2048 by 1536 pixels · CFP
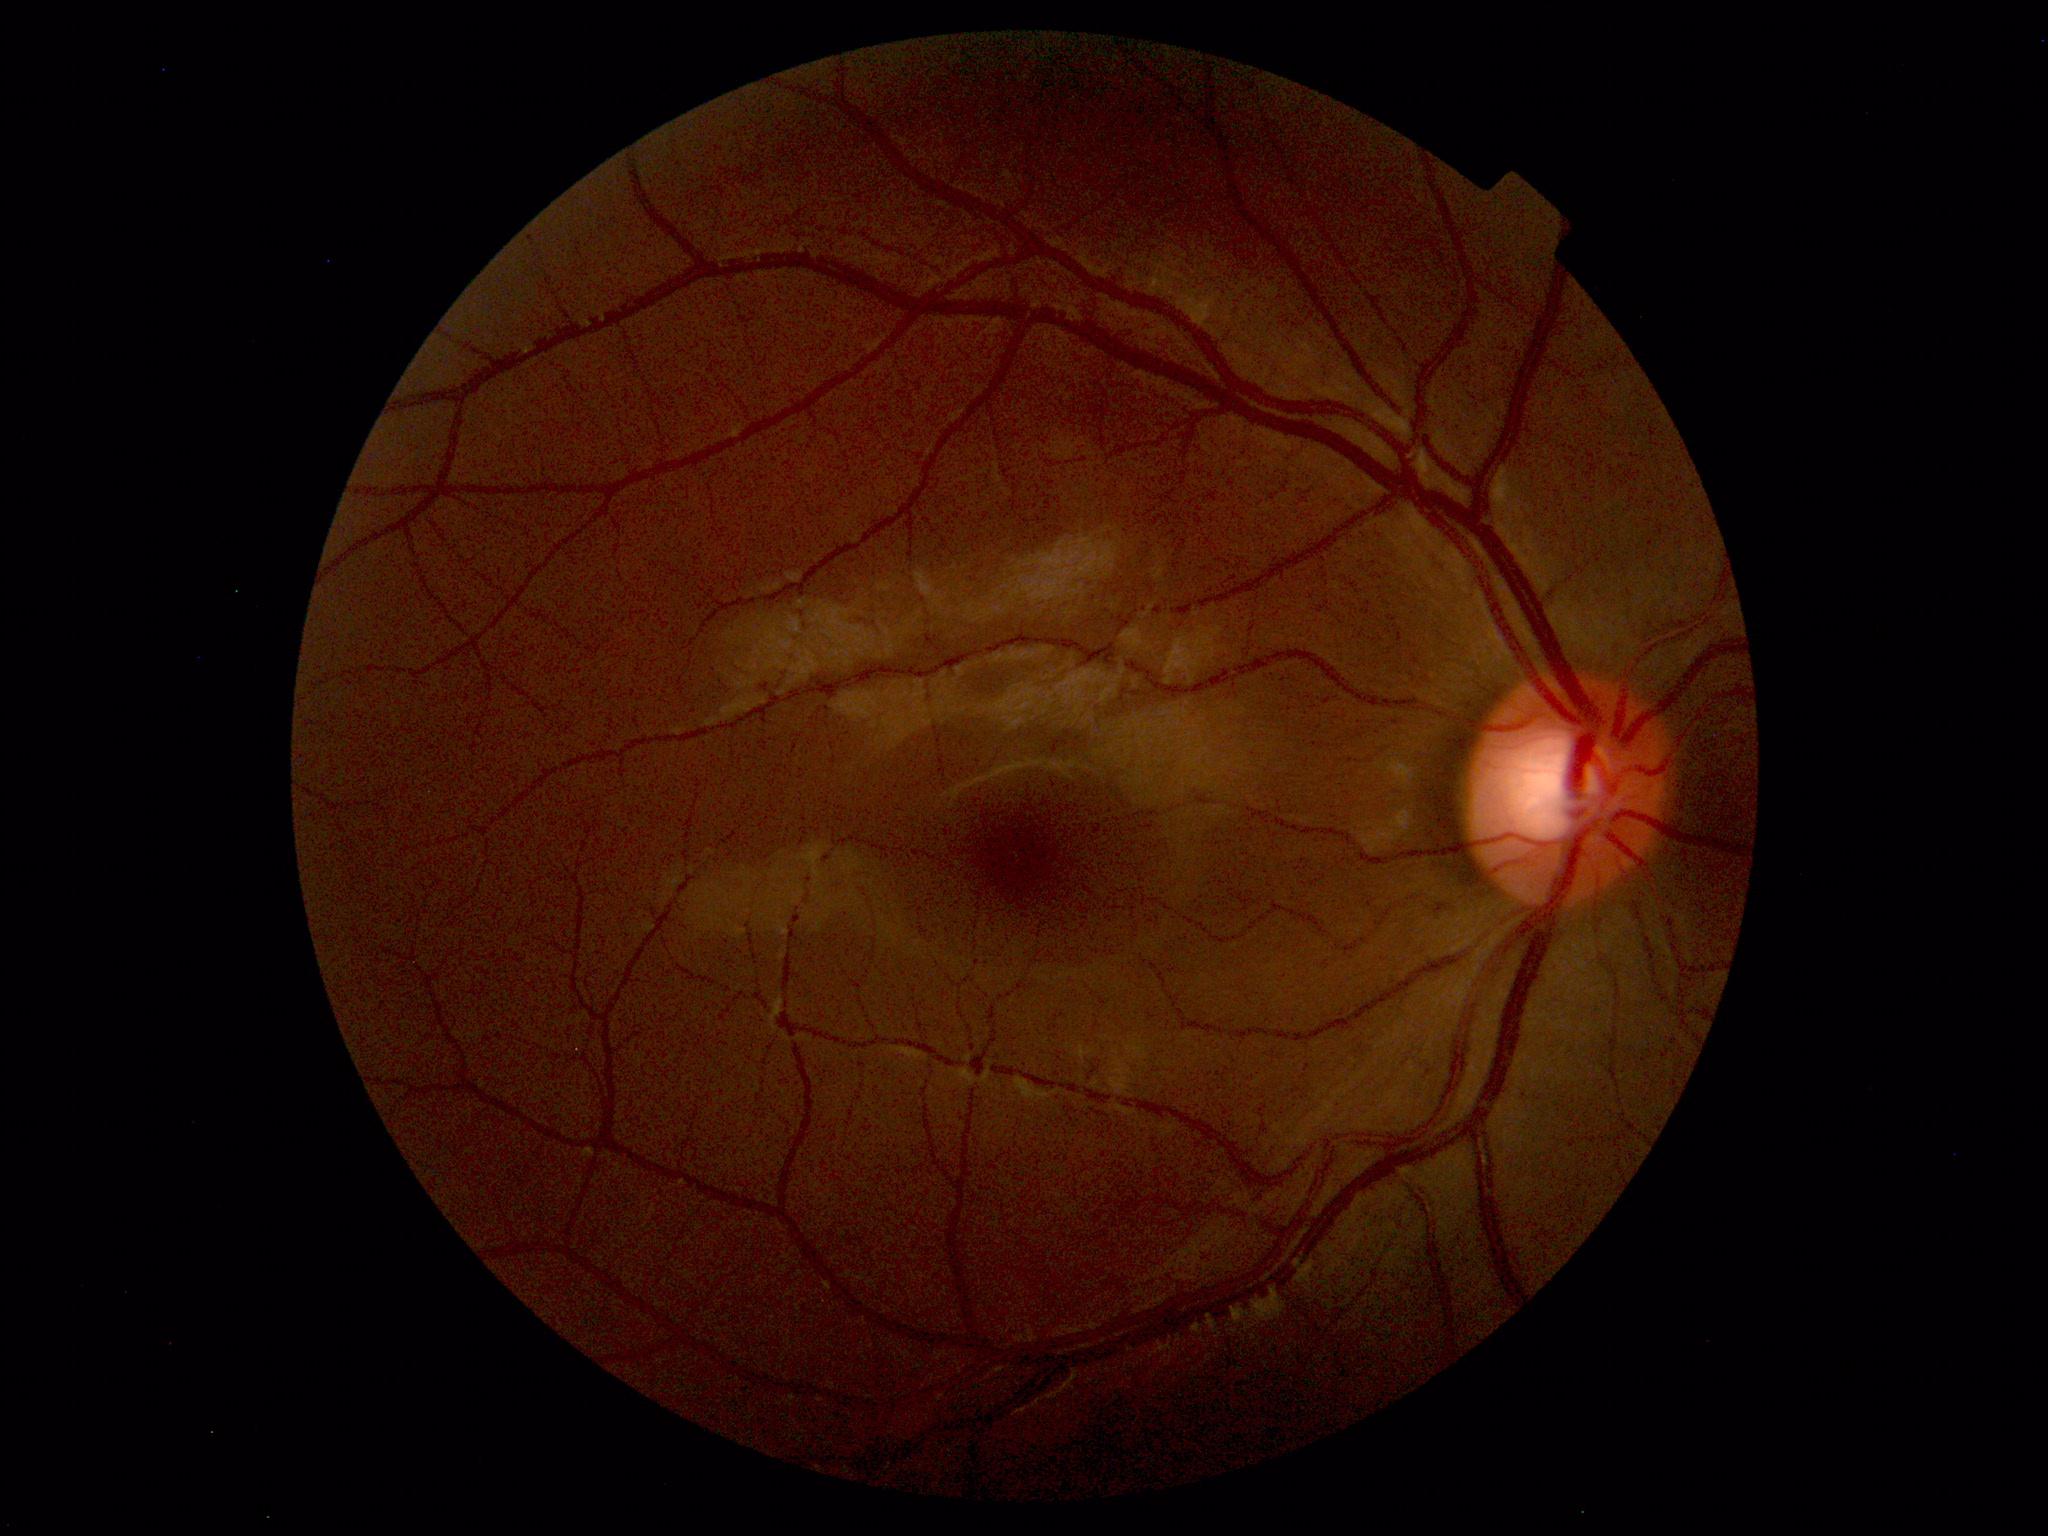 Findings: none. Normal fundus.